45° FOV · fundus photo — 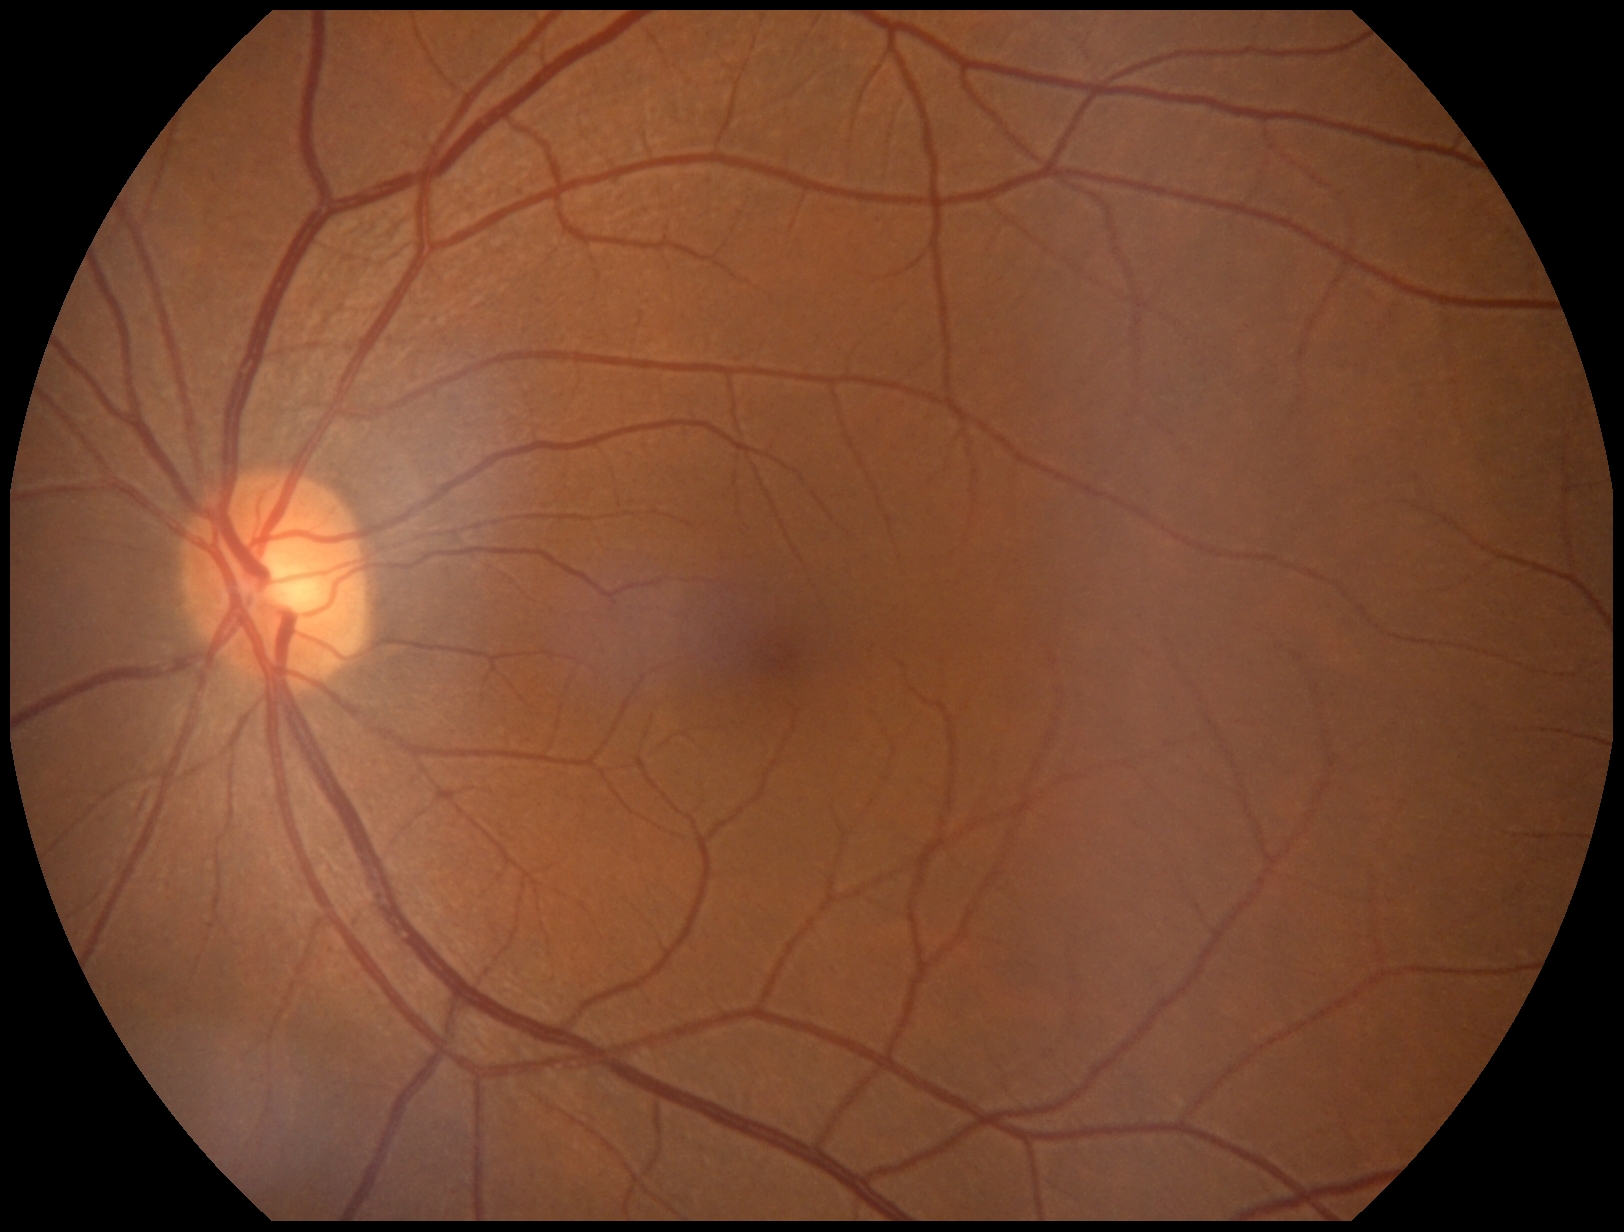   dr_grade: grade 0 (no apparent retinopathy)